Color fundus photograph; 2352x1568
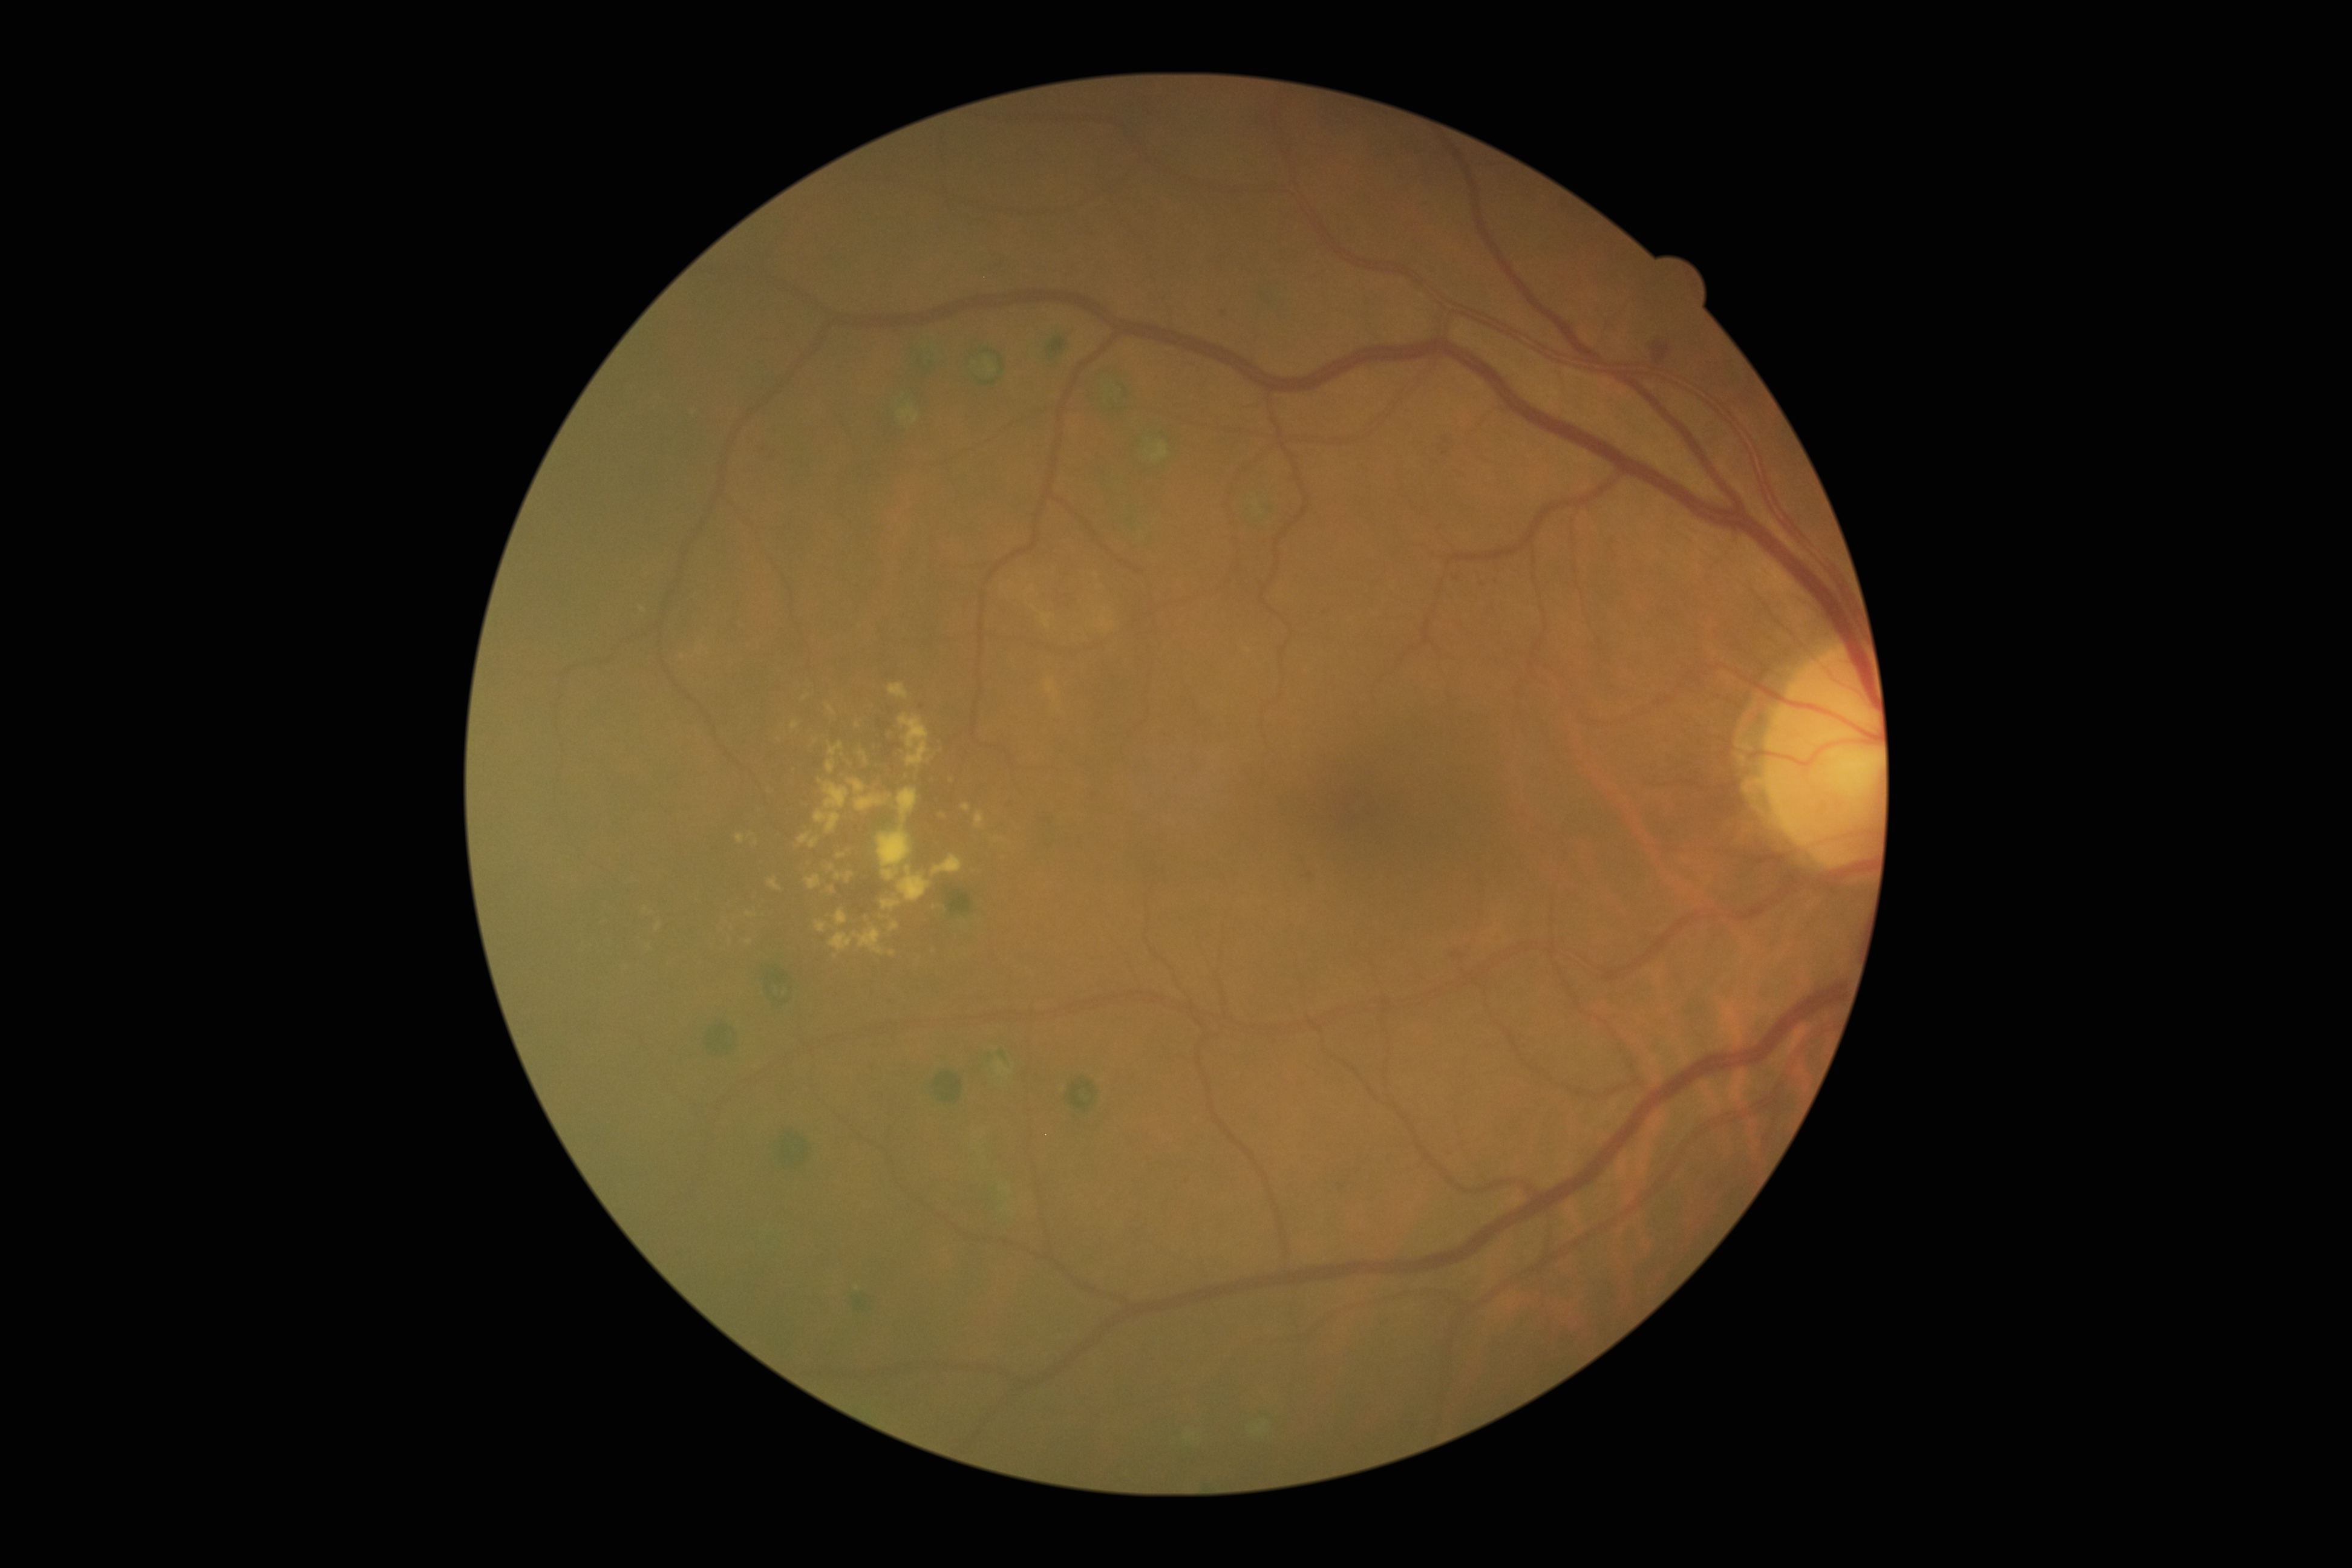 partial: true
dr_grade: 2
dr_grade_name: moderate NPDR
lesions:
  he:
    - (1652,342,1670,364)
  he_small_centers:
    - [1454, 956]
    - [1445, 454]
    - [1224, 313]
    - [1461, 956]
    - [1446, 439]
  se: []
  ma: []
  ex:
    - (878,826,912,881)
    - (854,927,884,954)
    - (746,912,756,918)
    - (655,923,662,931)
    - (932,855,964,875)
    - (835,872,855,884)
    - (881,900,901,910)
    - (828,706,837,716)
    - (838,854,846,858)
    - (829,742,843,756)
    - (829,932,854,950)
    - (817,921,827,933)
  ex_small_centers:
    - [750, 941]
    - [944, 816]